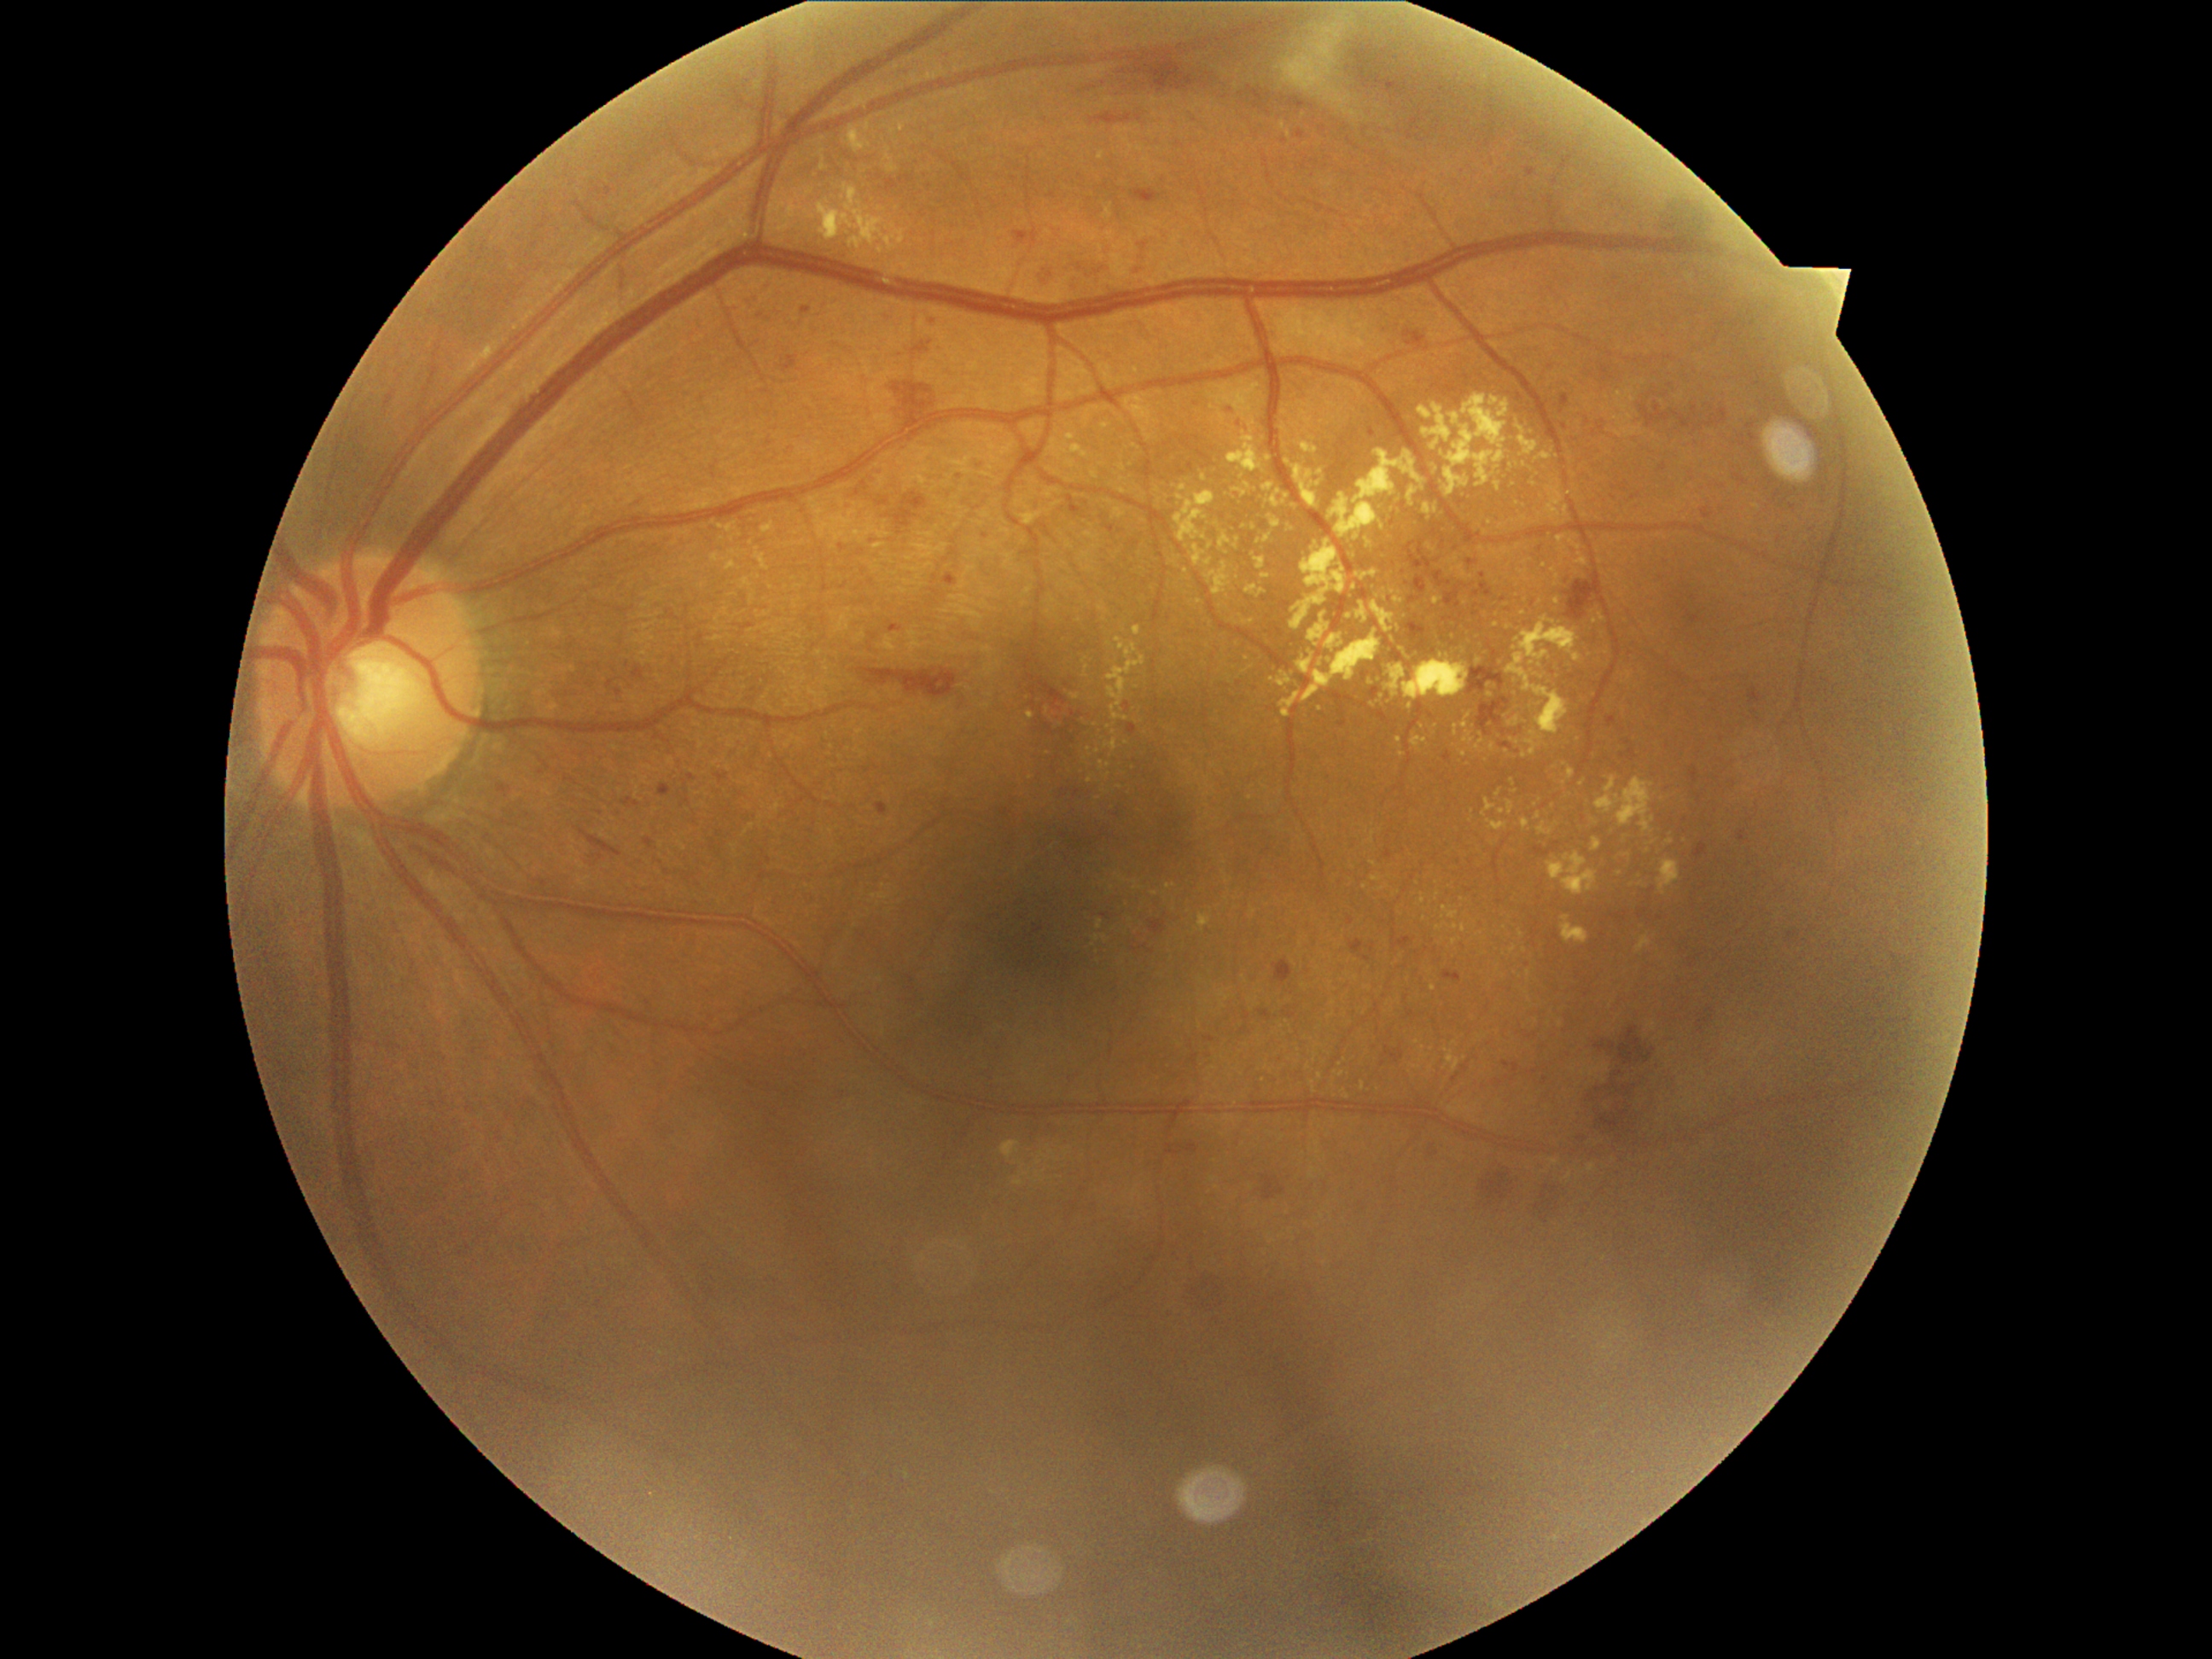
partial: true
dr_grade: 2
lesions:
  ma:
    - <box>1226,405,1237,416</box>
    - <box>1015,231,1028,243</box>
    - <box>1298,131,1307,139</box>
    - <box>1689,769,1699,784</box>
    - <box>1368,943,1377,955</box>
    - <box>1102,912,1112,921</box>
    - <box>1141,945,1150,952</box>
    - <box>1126,701,1131,713</box>
    - <box>1633,494,1641,501</box>
    - <box>1559,393,1569,414</box>
    - <box>1134,265,1146,276</box>
    - <box>1148,950,1156,955</box>
    - <box>718,774,731,784</box>
    - <box>1503,1061,1522,1074</box>
    - <box>781,356,800,373</box>
  ma_small_centers:
    - 1721:488
    - 1601:428
    - 1755:712
  ex:
    - <box>1086,776,1095,784</box>
    - <box>1223,873,1231,883</box>
    - <box>1563,506,1568,518</box>
    - <box>1491,743,1496,754</box>
    - <box>1445,393,1511,498</box>
    - <box>1298,651,1315,675</box>
    - <box>1658,859,1680,895</box>
    - <box>718,527,733,533</box>
    - <box>1271,491,1283,508</box>
    - <box>1356,603,1368,624</box>
  ex_small_centers:
    - 1098:752
    - 1252:667
    - 1199:602
    - 1348:1098
    - 1356:979
    - 1740:768
    - 1455:1042
    - 1508:752
    - 1513:782
  he:
    - <box>1274,960,1295,986</box>
    - <box>892,378,940,434</box>
    - <box>600,678,622,697</box>
    - <box>1441,538,1447,549</box>
    - <box>1481,1172,1516,1206</box>
    - <box>1433,571,1452,588</box>
    - <box>1284,1006,1298,1020</box>
    - <box>1150,921,1167,936</box>
    - <box>1163,1138,1202,1155</box>
    - <box>1445,970,1462,982</box>
    - <box>1467,559,1479,566</box>
    - <box>1404,542,1433,576</box>
    - <box>902,492,928,511</box>
    - <box>887,175,914,192</box>
    - <box>1641,404,1670,429</box>
    - <box>1409,631,1423,646</box>
    - <box>1566,579,1598,620</box>
    - <box>1469,646,1506,696</box>
  he_small_centers:
    - 1438:560
    - 1457:547